Pediatric retinal photograph (wide-field); Phoenix ICON, 100° FOV.
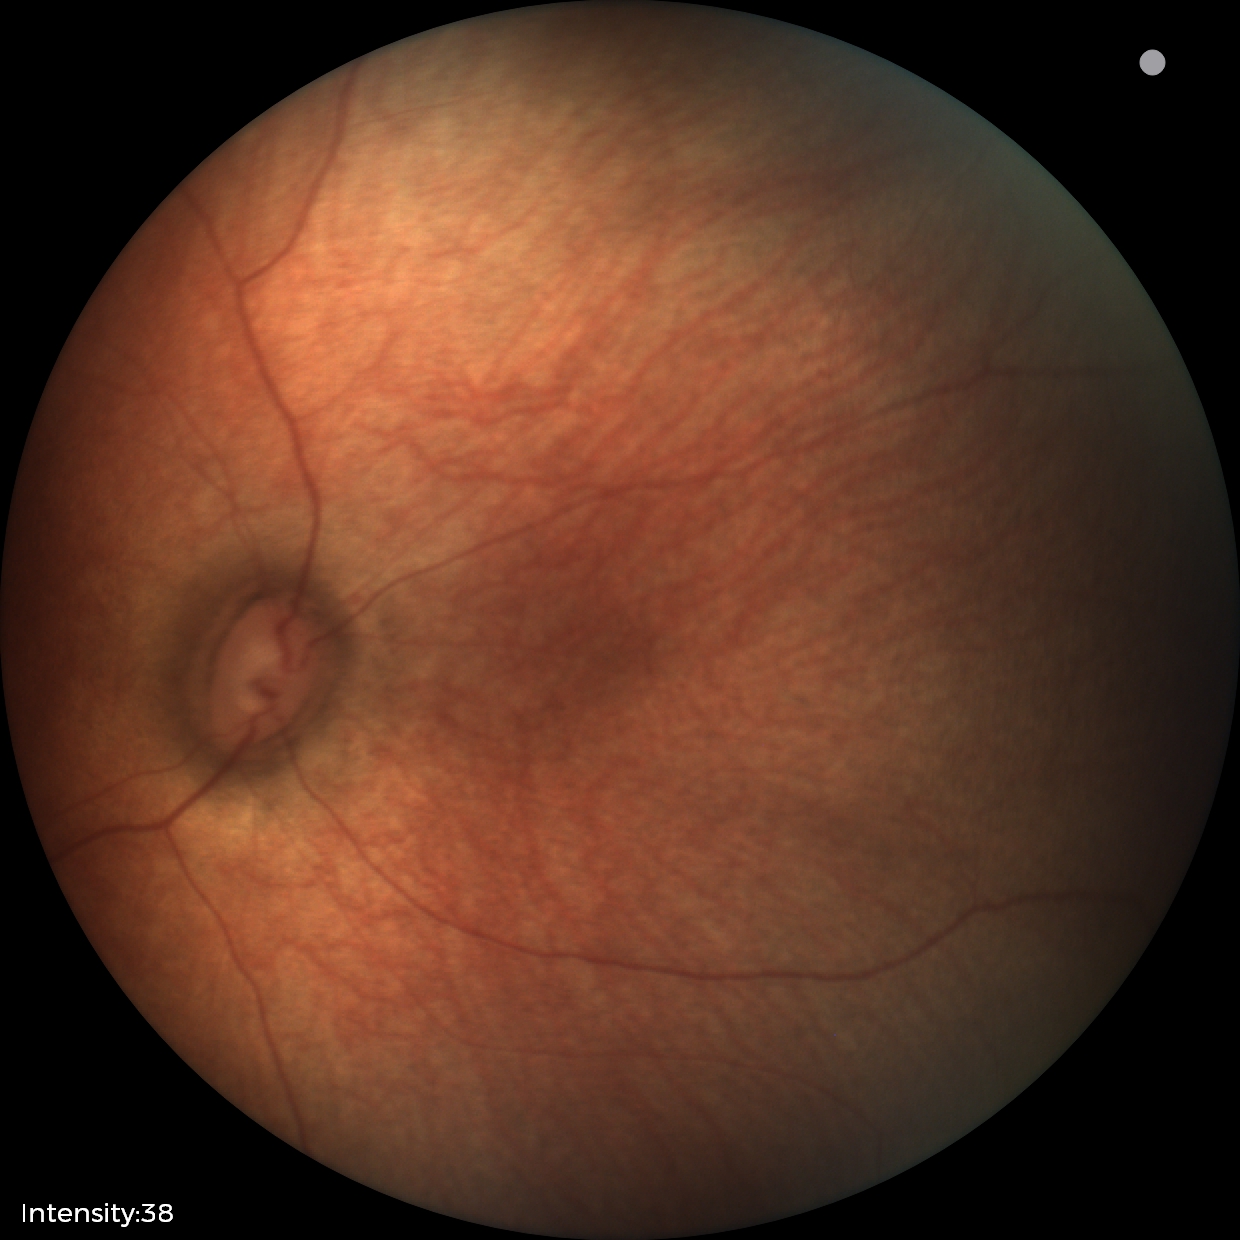
Screening diagnosis: no abnormalities.